2212 x 1659 pixels — 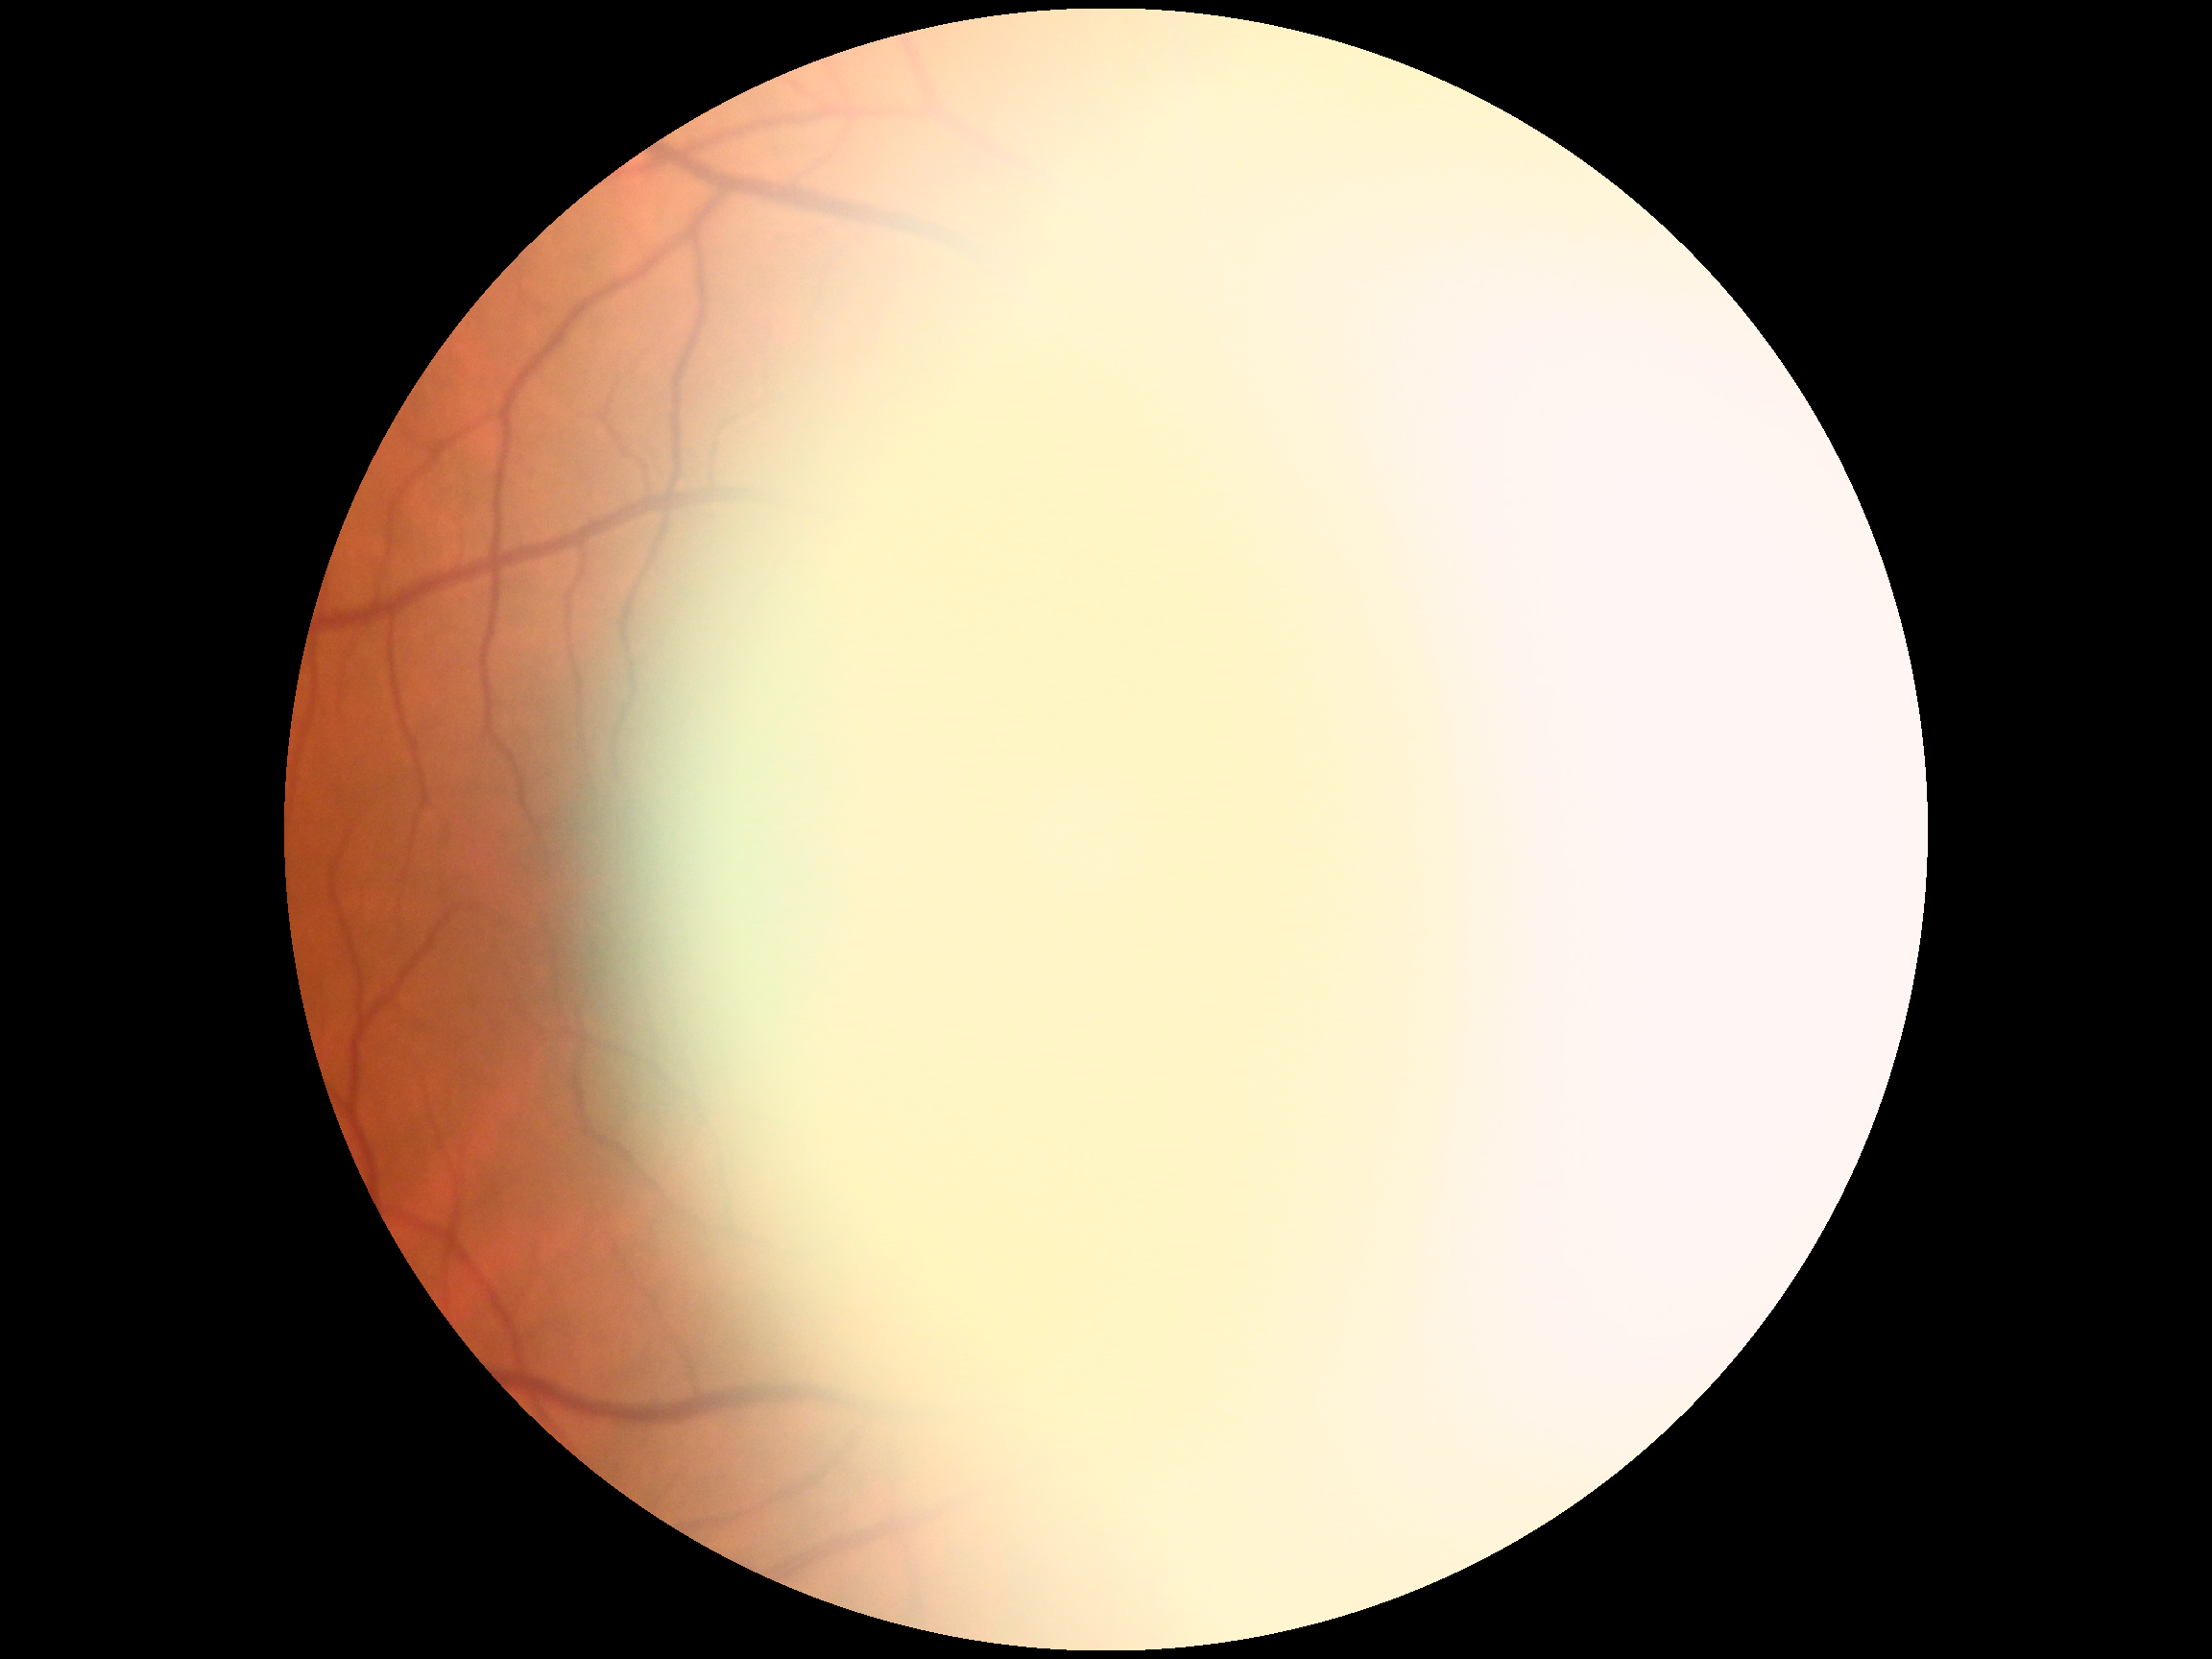

{"dr_grade": "ungradable", "quality": "too poor for DR grading"}